Pediatric wide-field fundus photograph · captured with the Phoenix ICON (100° field of view):
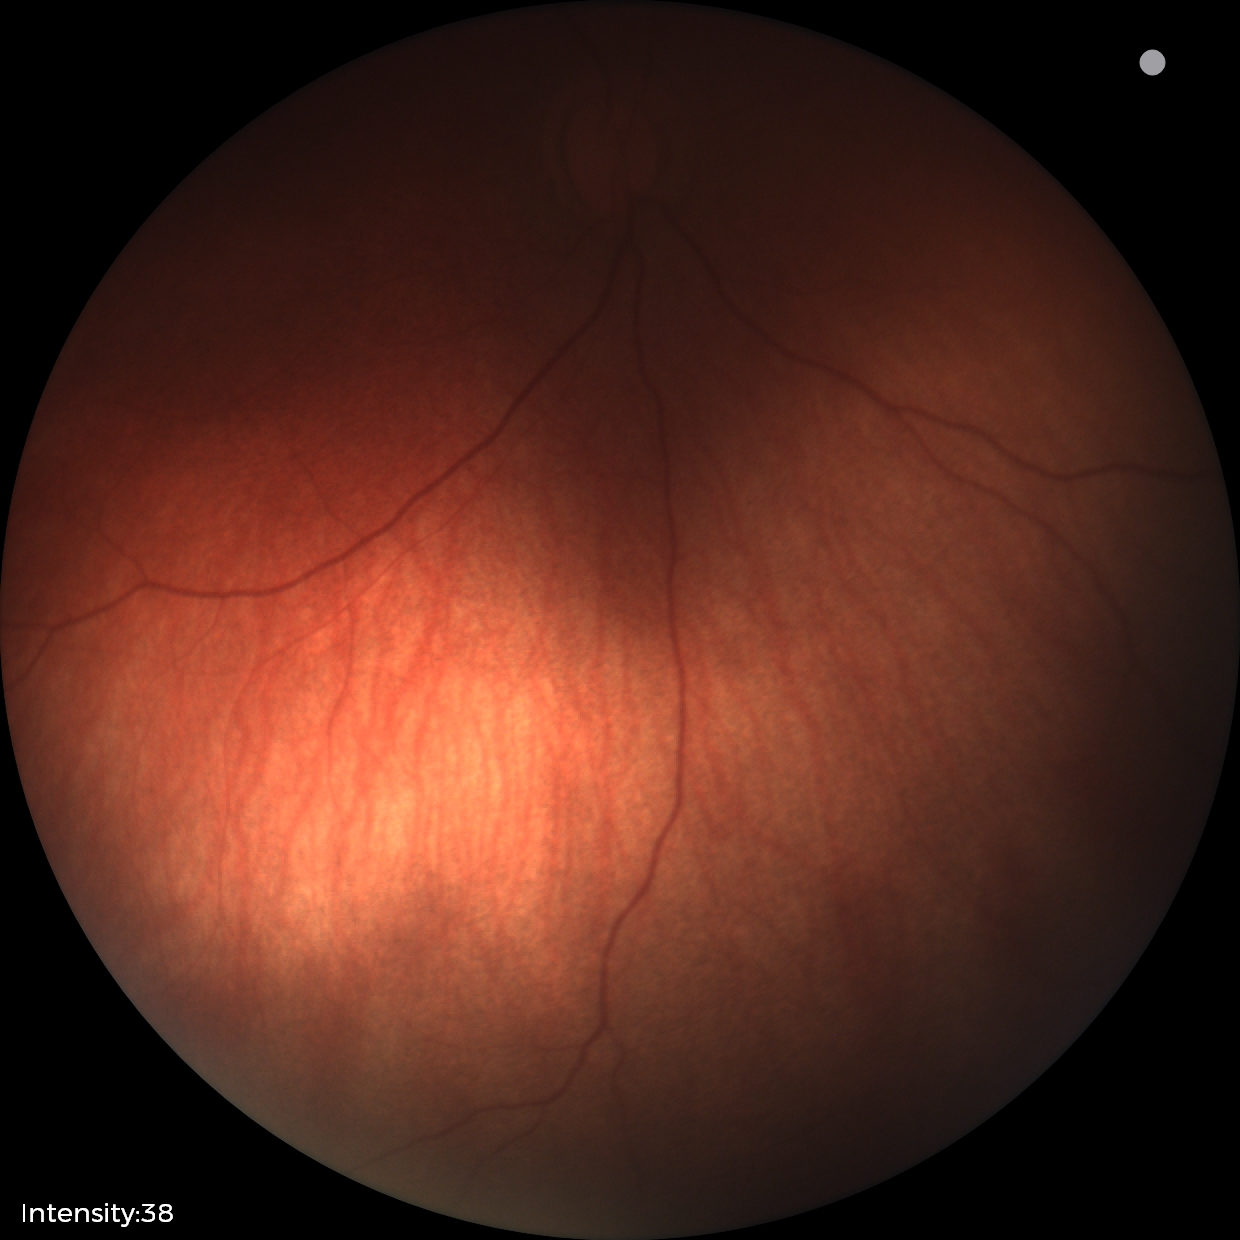 Examination with physiological retinal findings.